Camera: NIDEK AFC-230, posterior pole color fundus photograph, nonmydriatic, 848x848px:
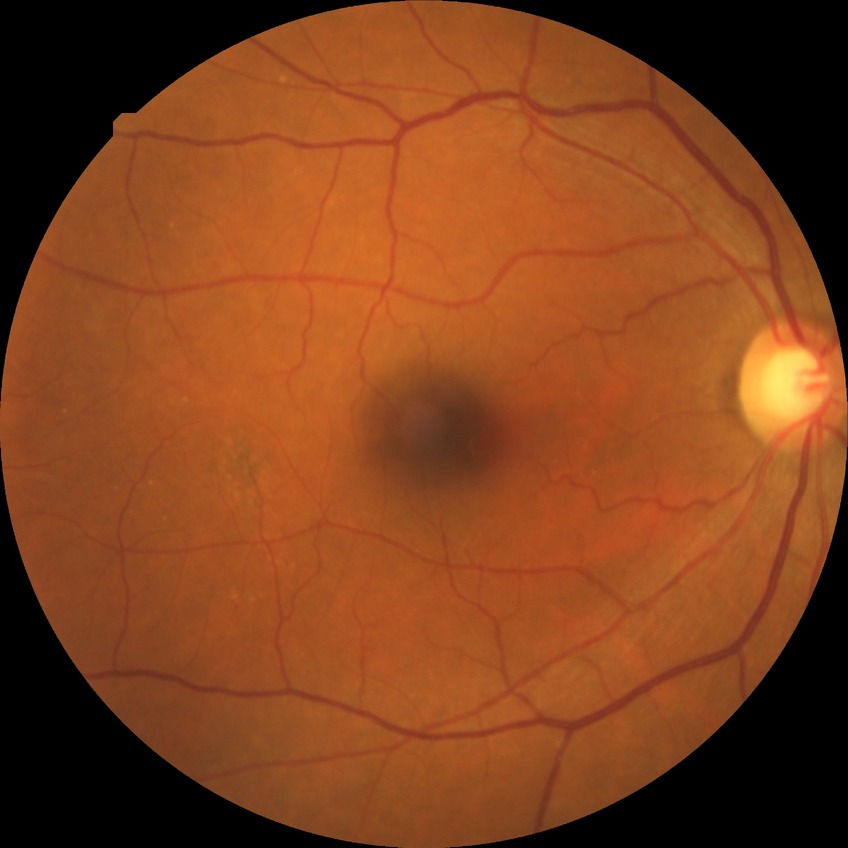

No DR findings.
Modified Davis grade: NDR.